Phoenix ICON, 100° FOV; wide-field fundus photograph from neonatal ROP screening:
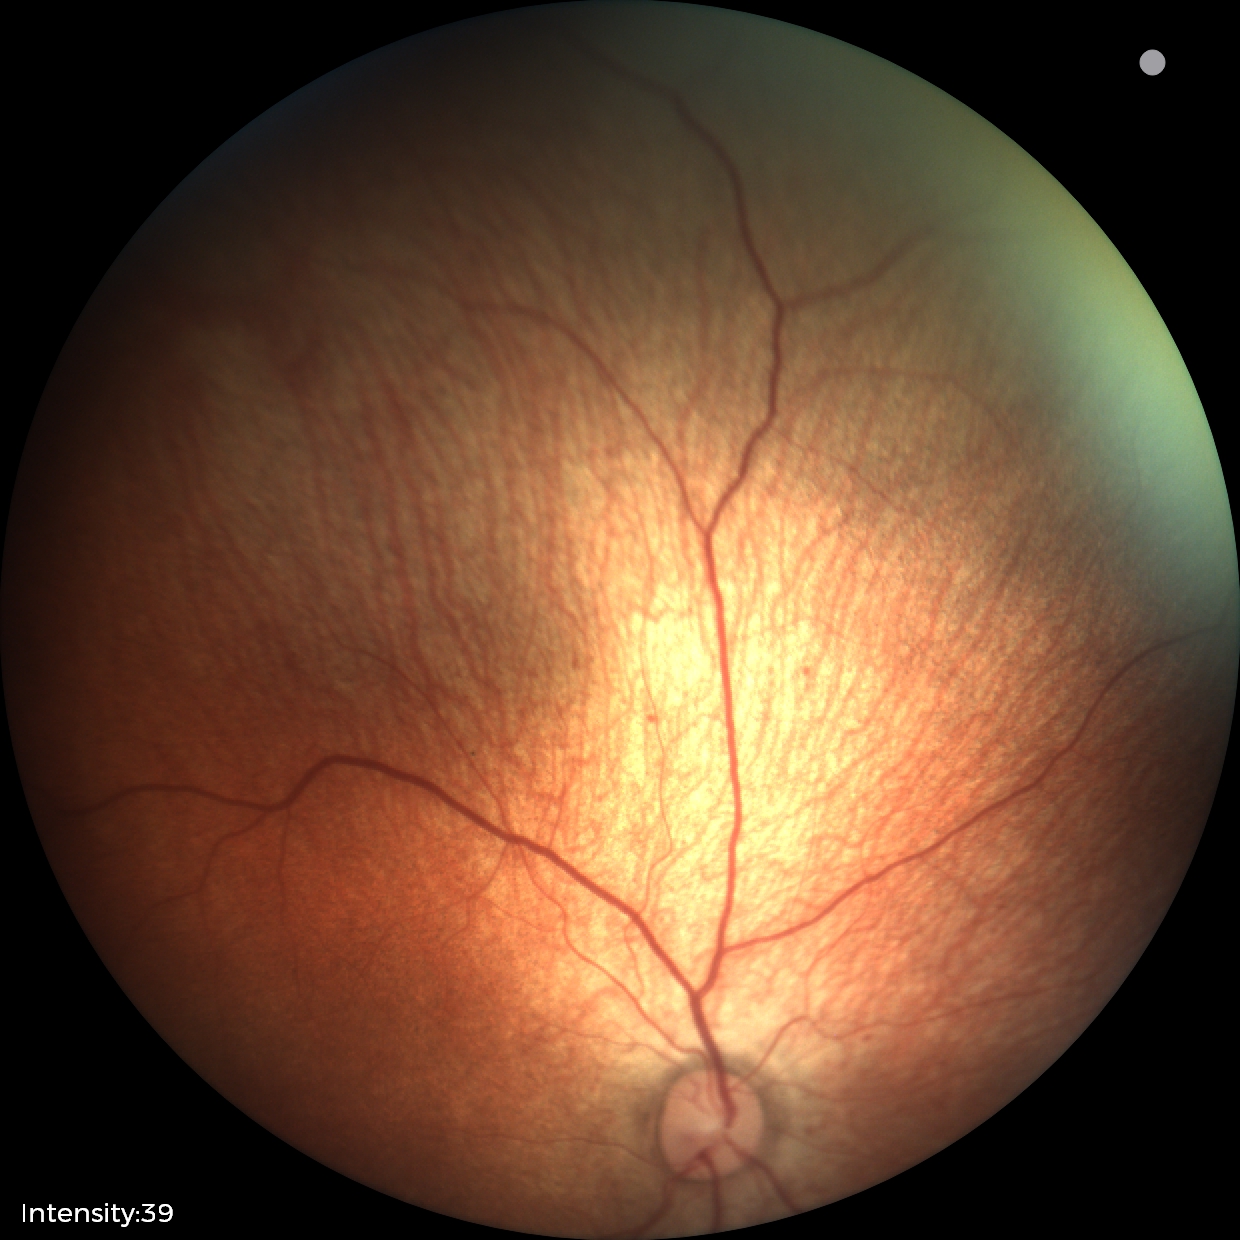 Impression: physiological retinal finding.